2048 by 1536 pixels, 45° field of view, color fundus image: 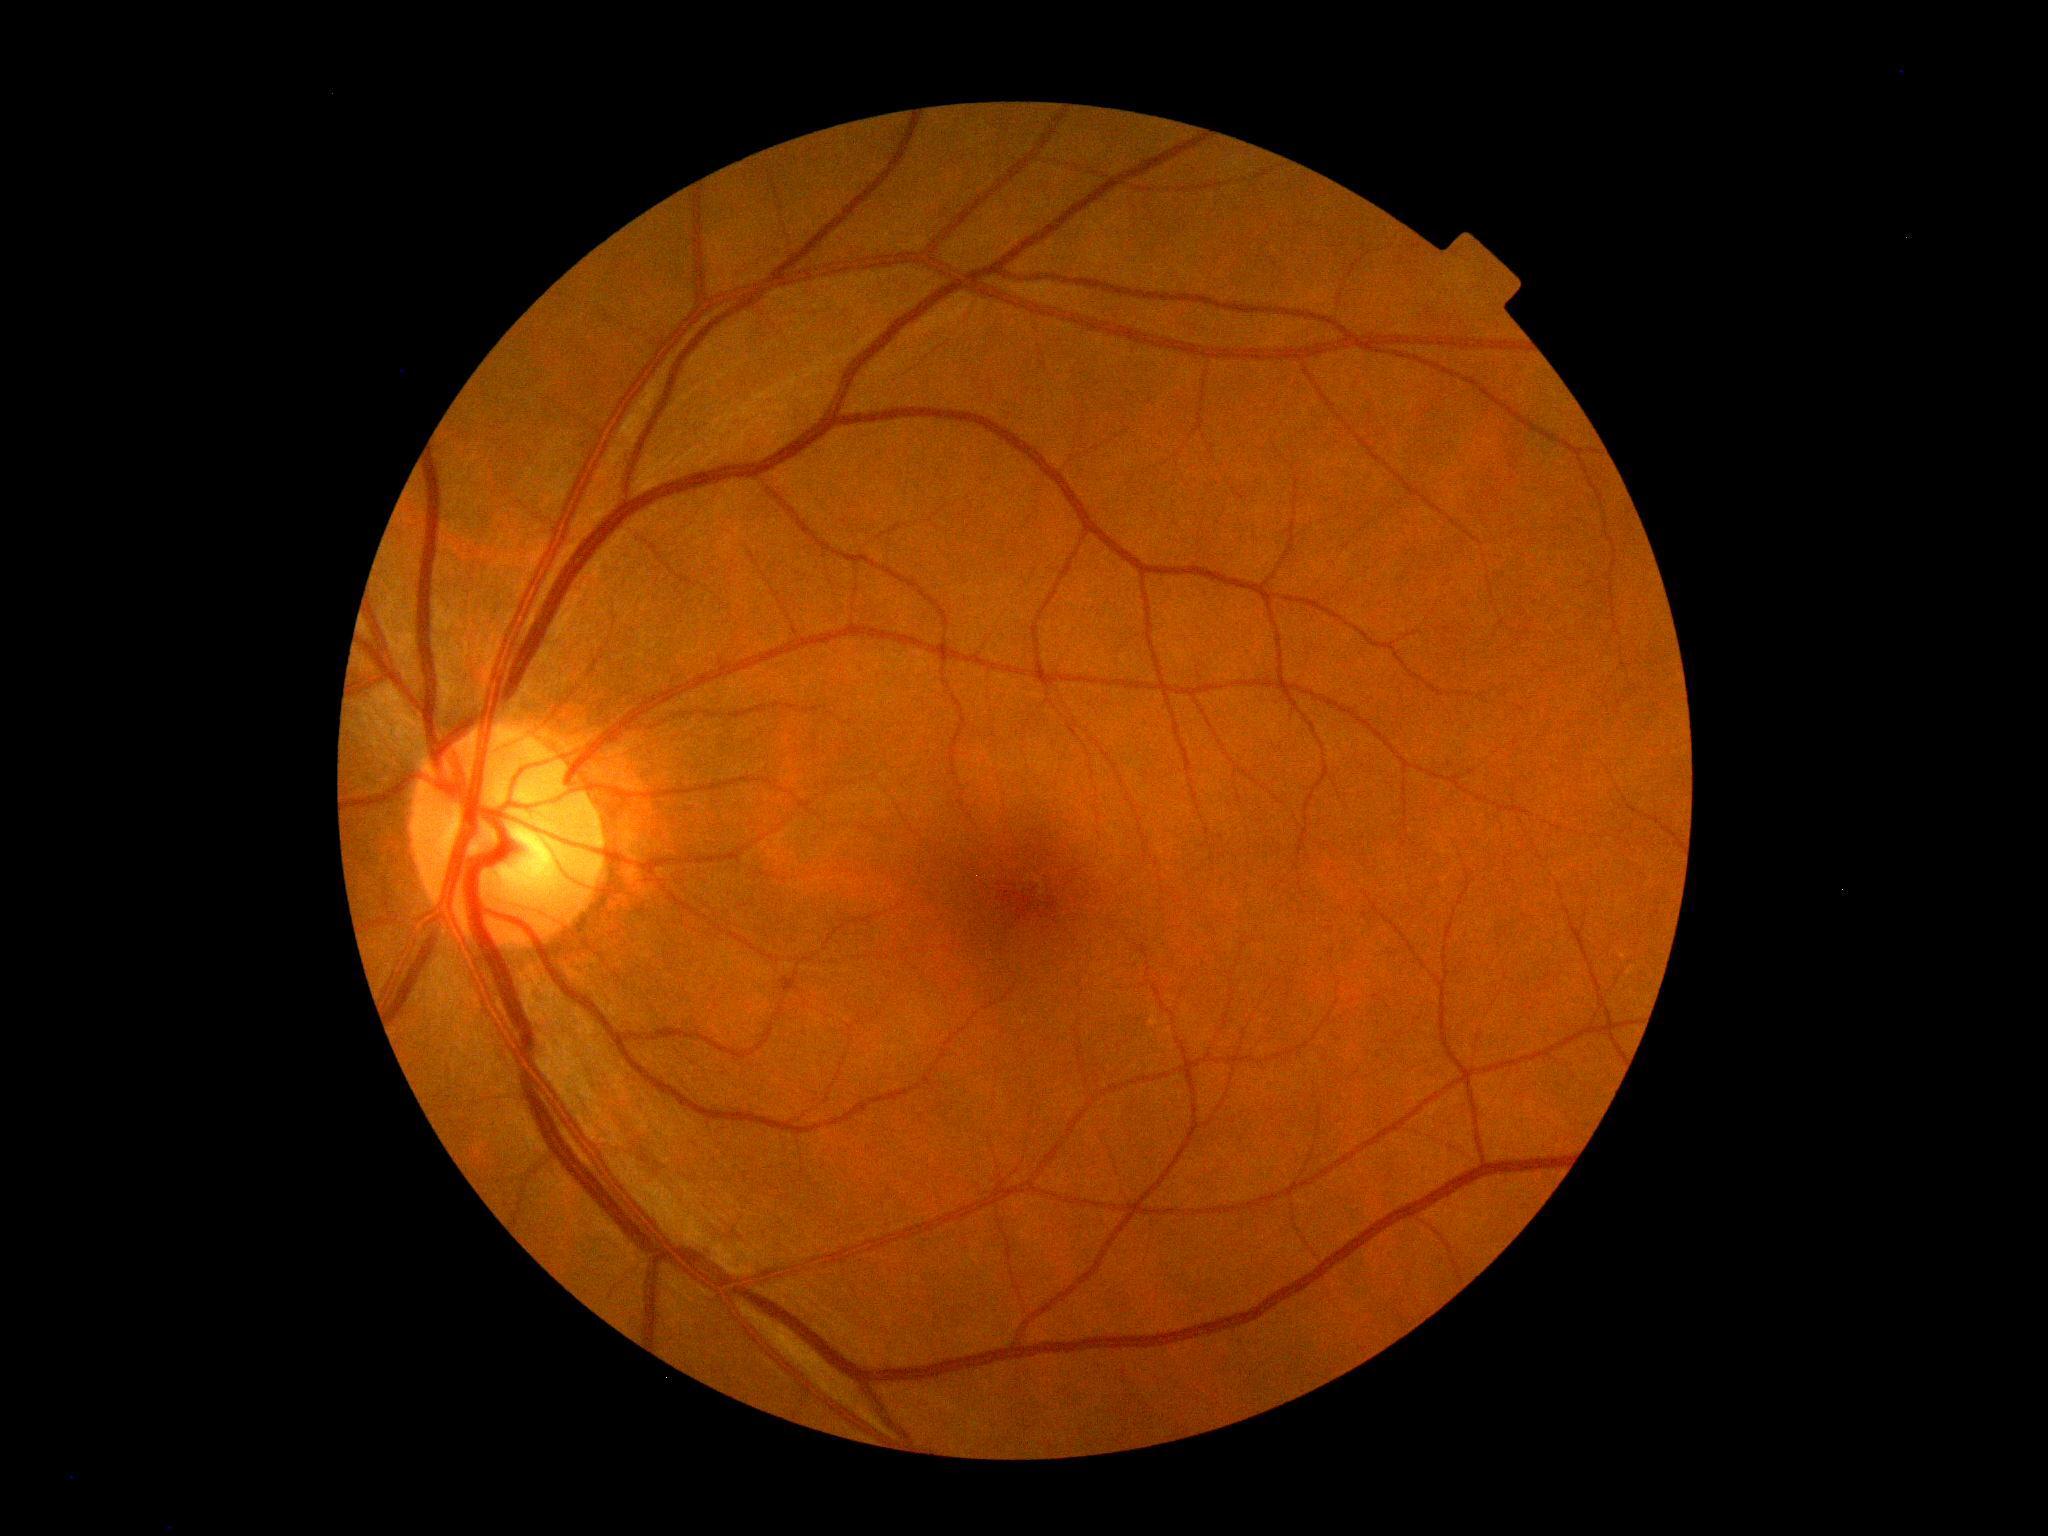 DR impression = no apparent DR; DR grade = 0/4.